Posterior pole view:
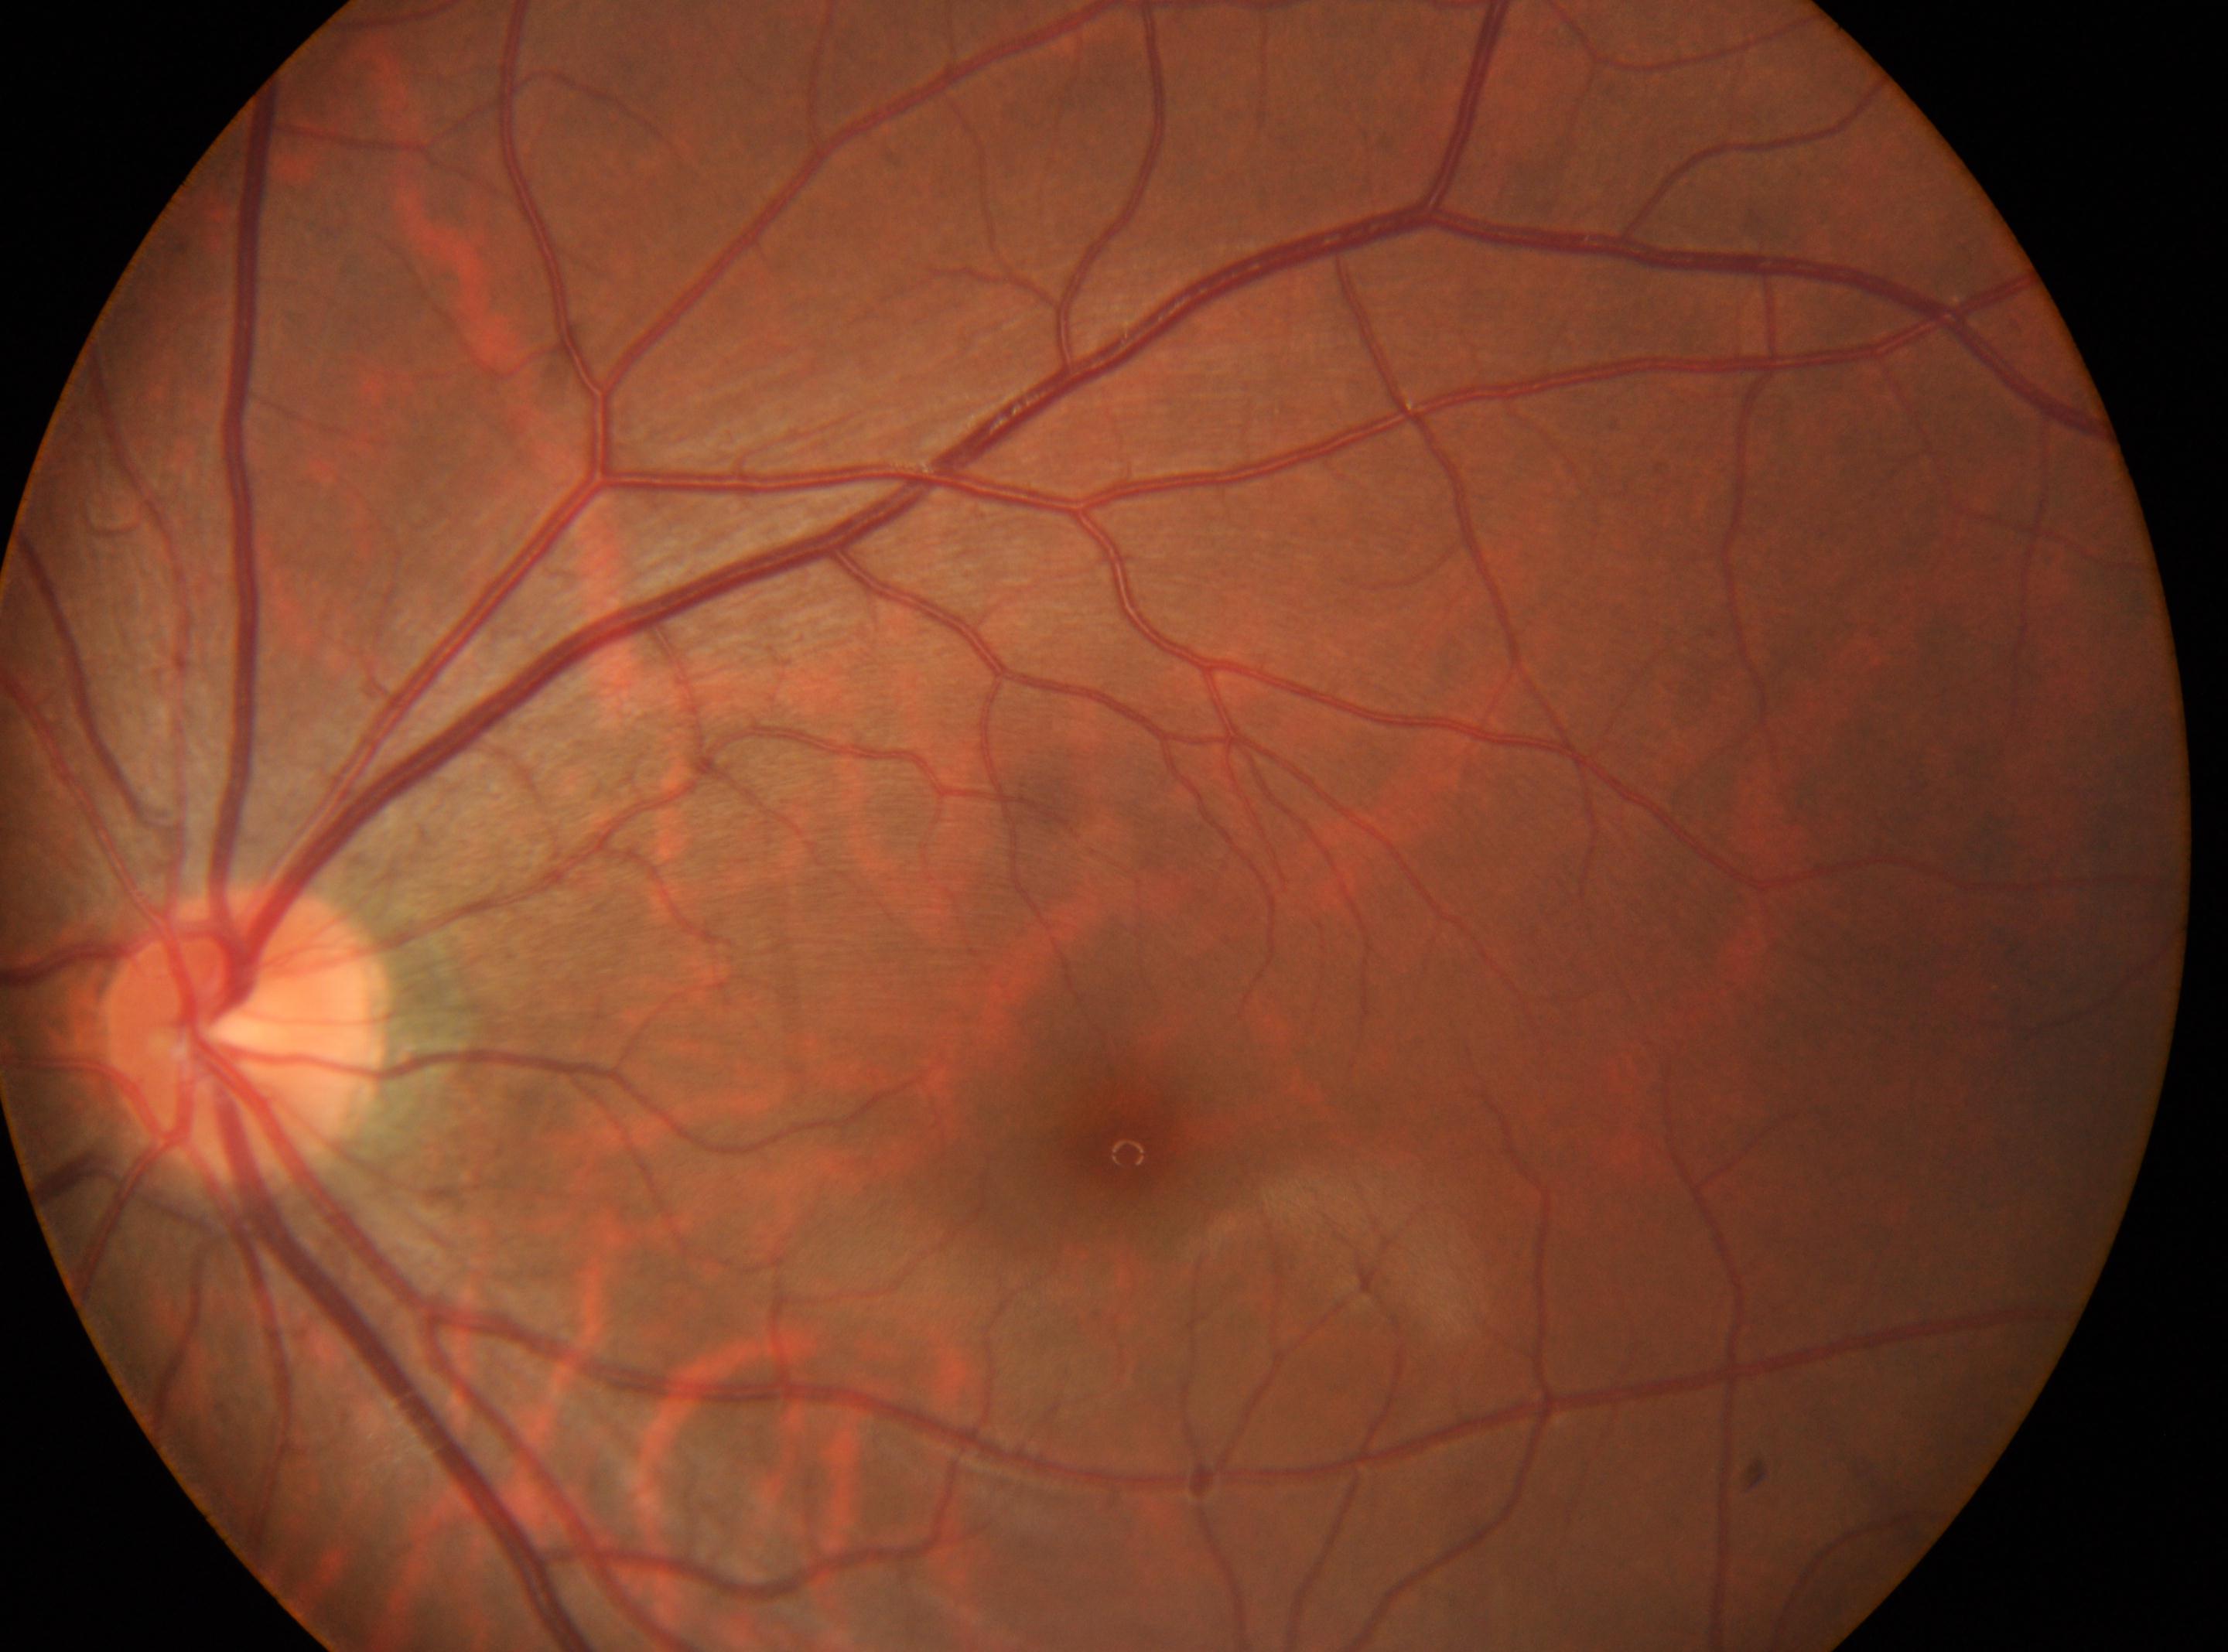 Diabetic retinopathy grade is 0 (no apparent retinopathy) — no visible signs of diabetic retinopathy.
Macular center: [1126, 1149].
The optic disc is at [239, 1033].
No diabetic retinal disease findings.
This is the left eye.